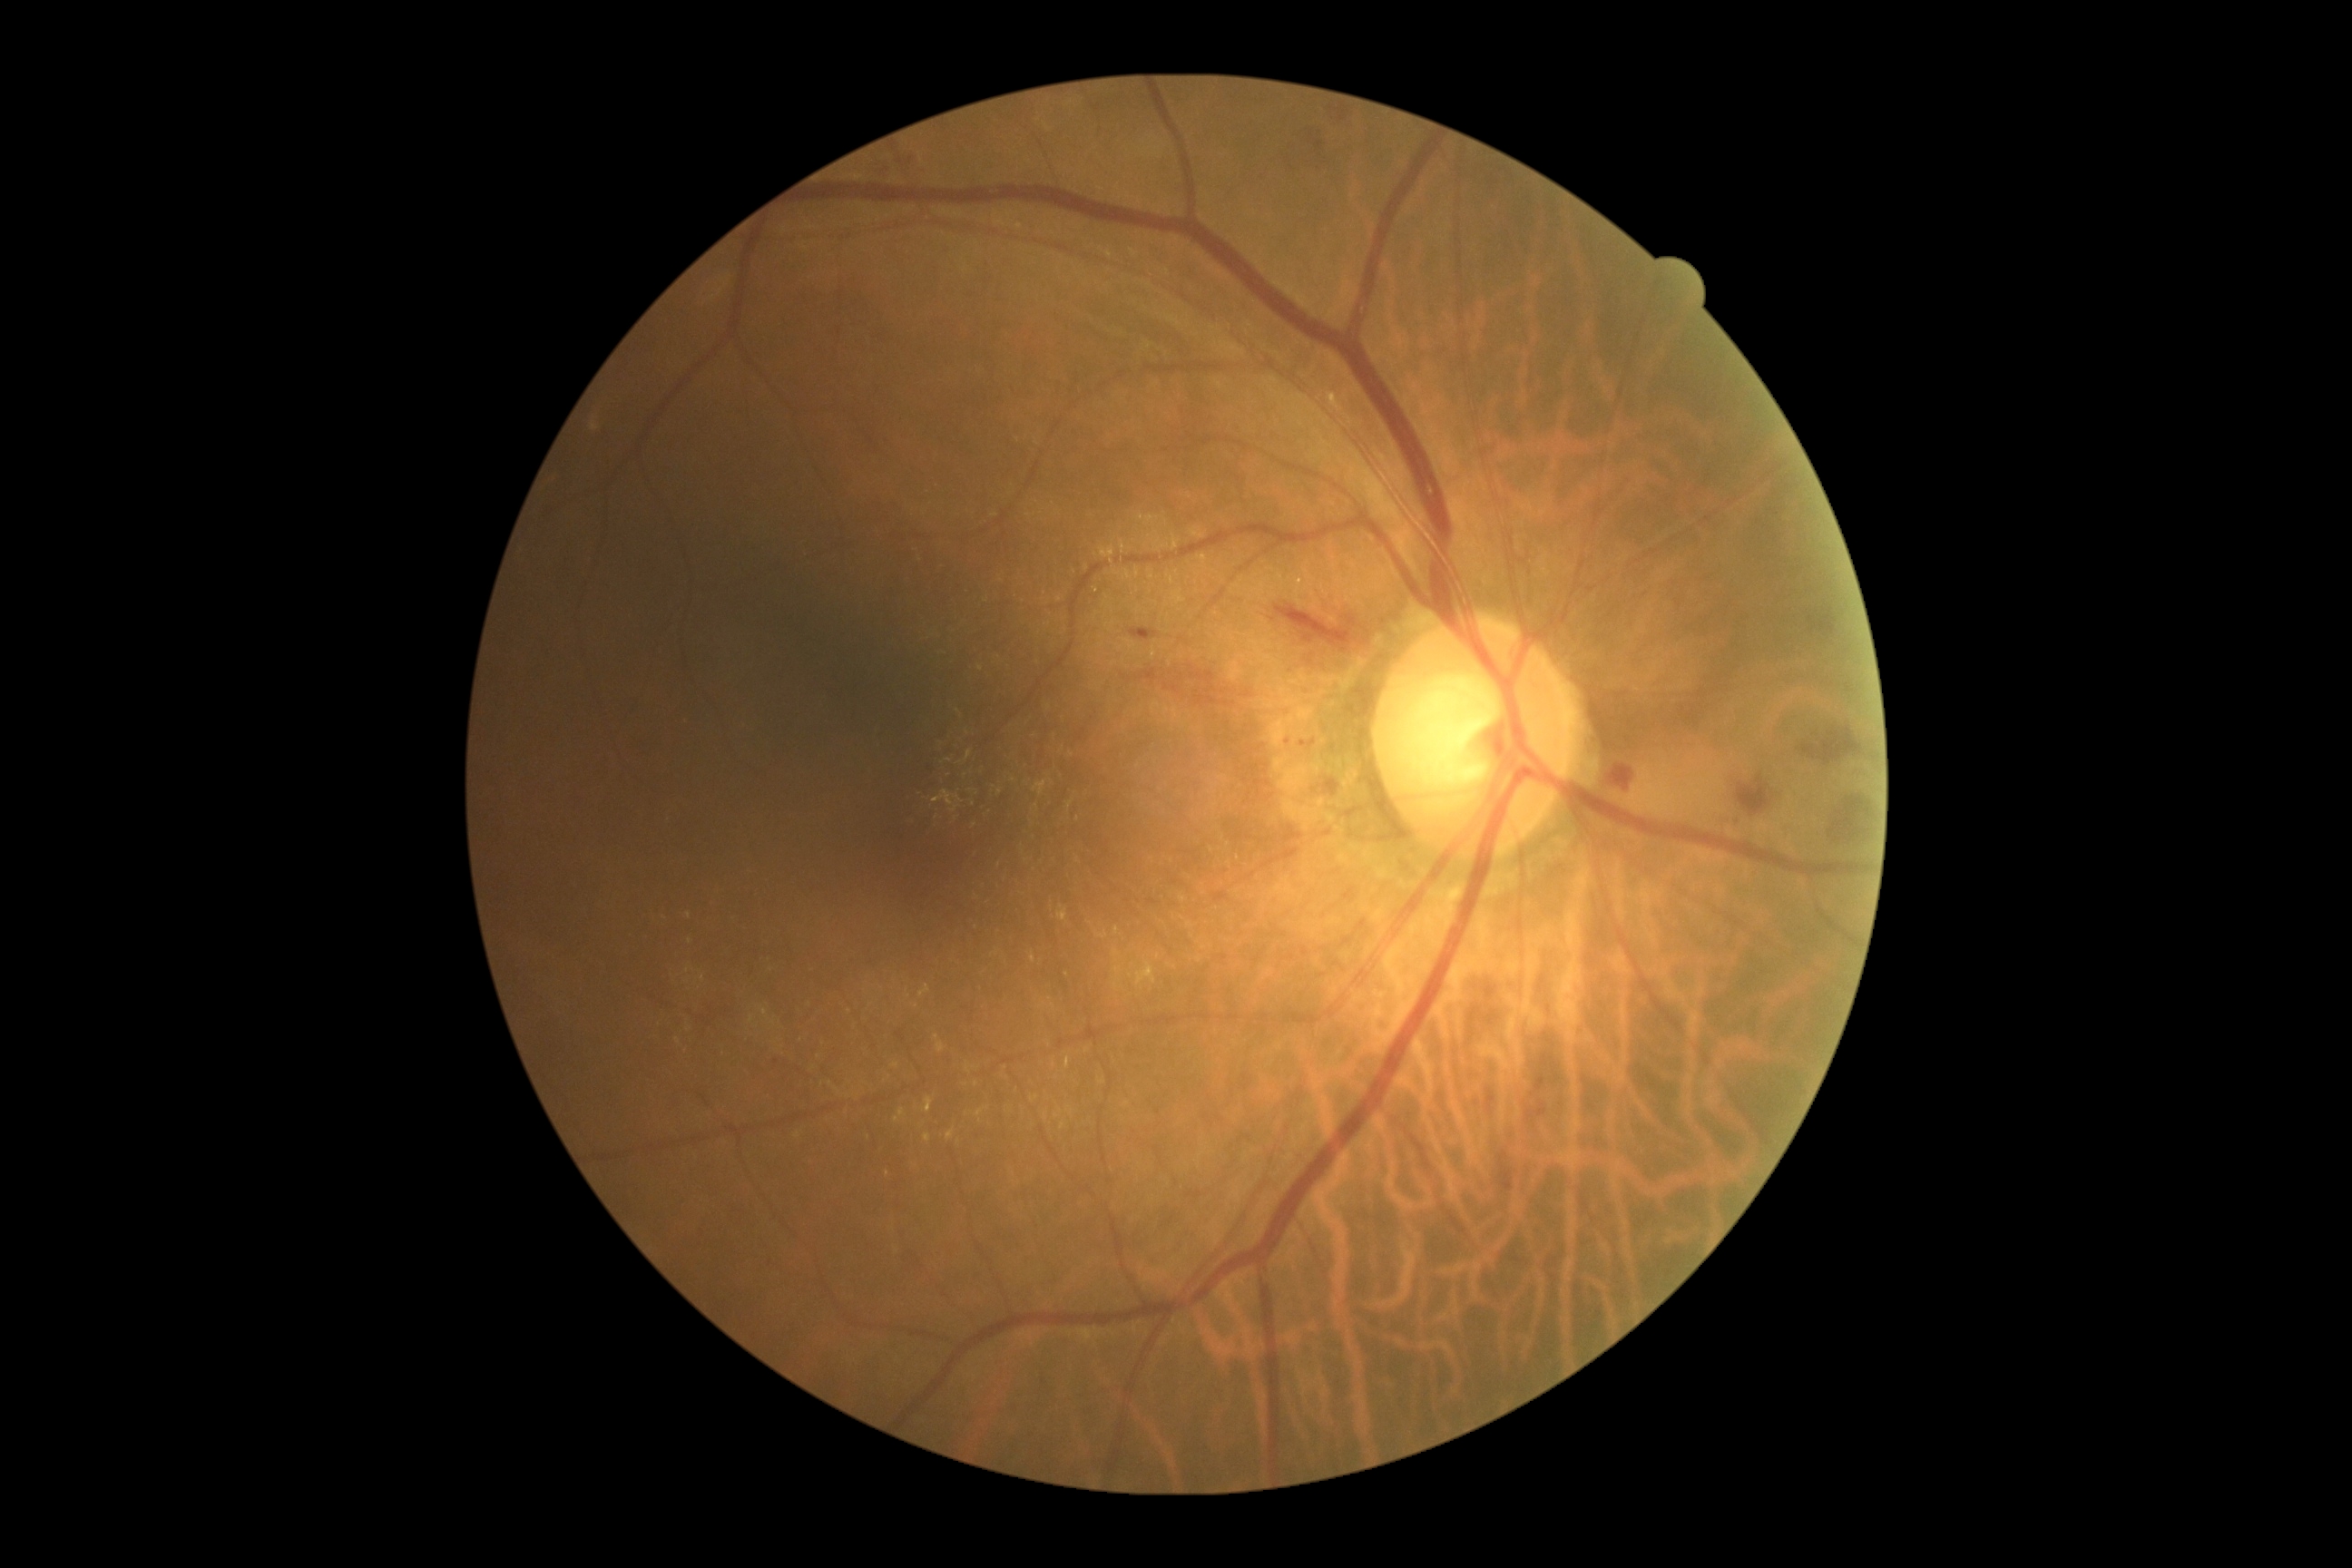 DR severity is grade 2. The retinopathy is classified as non-proliferative diabetic retinopathy.